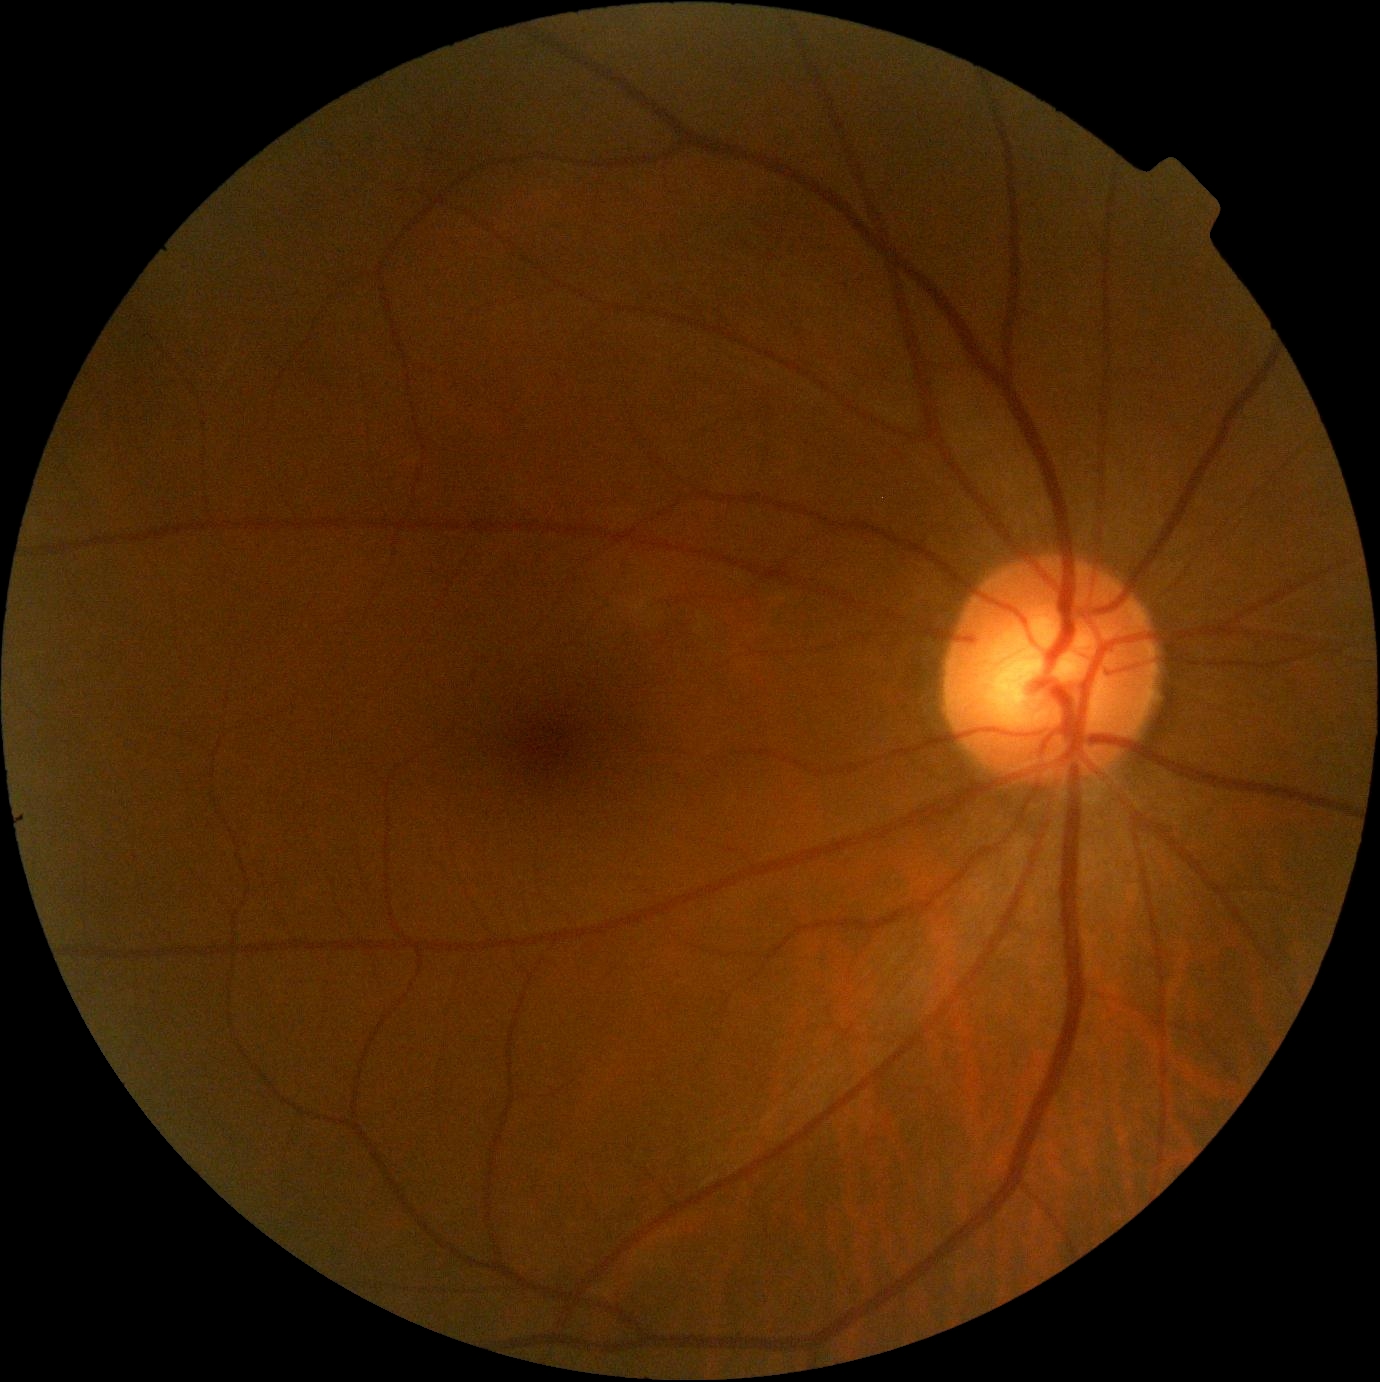 Annotations:
– DR impression: no apparent DR
– diabetic retinopathy severity: grade 0 (no apparent retinopathy) — no visible signs of diabetic retinopathy